Captured with the Clarity RetCam 3 (130° field of view) · image size 640x480 · pediatric wide-field fundus photograph.
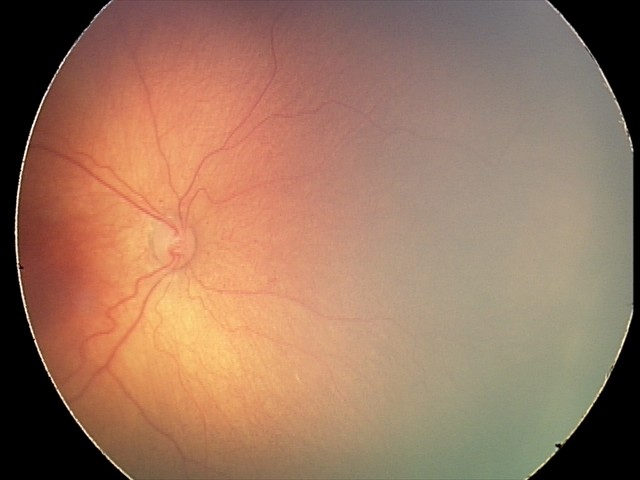

From an examination with diagnosis of ROP stage 2 — ridge with height and width at the demarcation line.